Retinal fundus photograph · 2048 x 1536 pixels
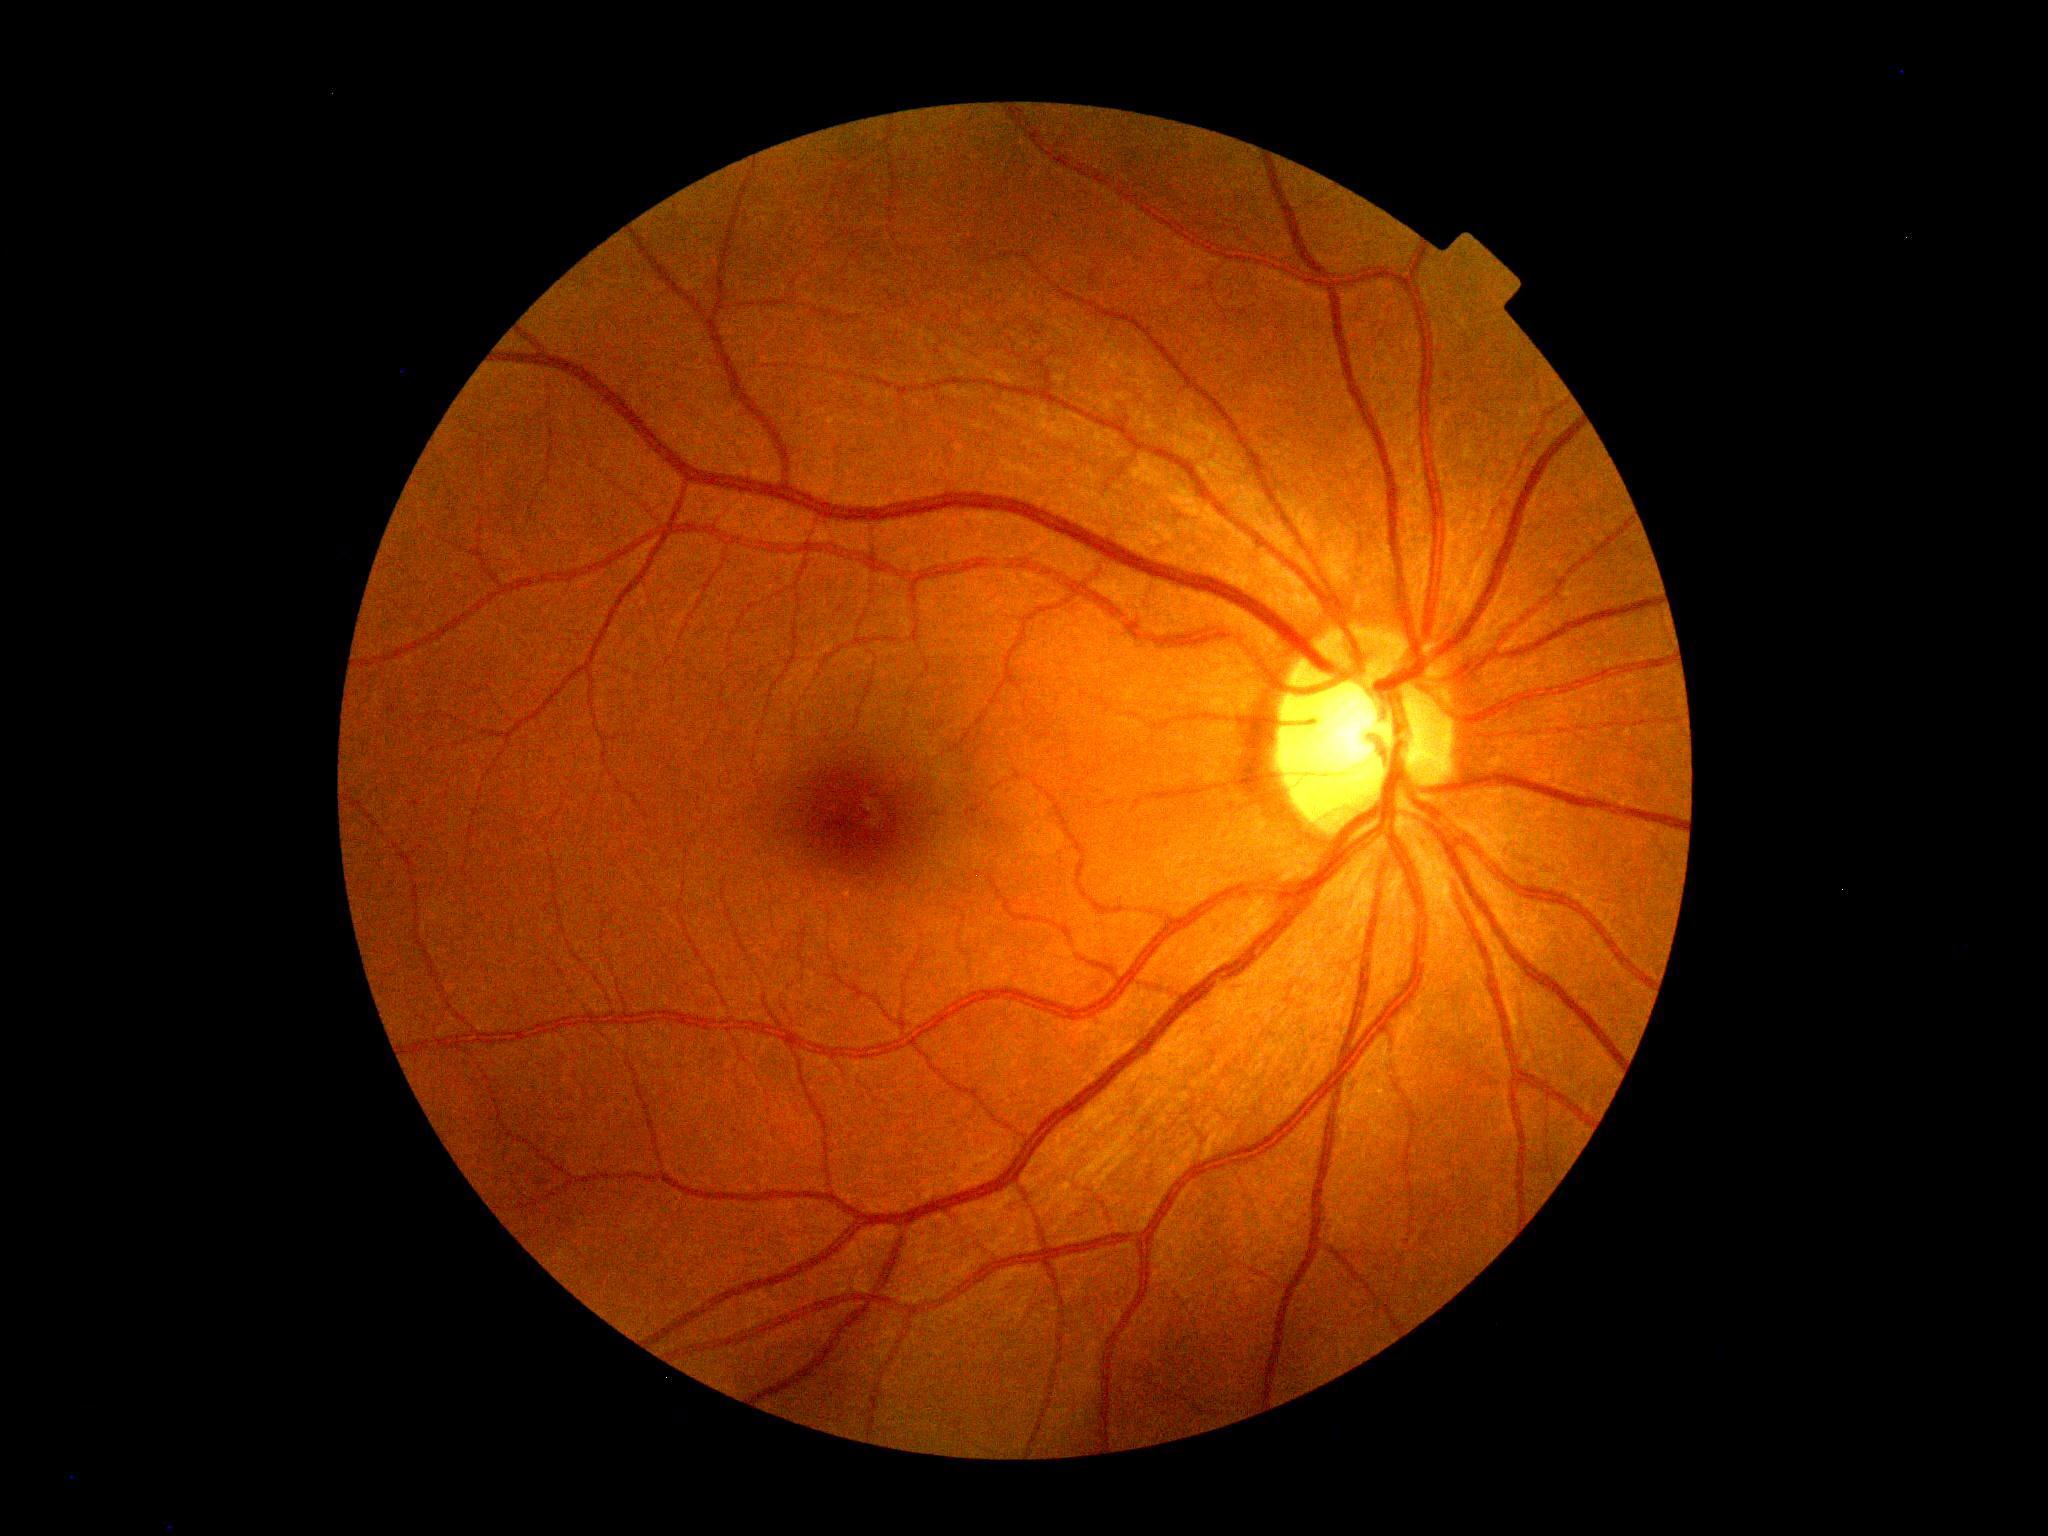

Diabetic retinopathy (DR) is 0/4.